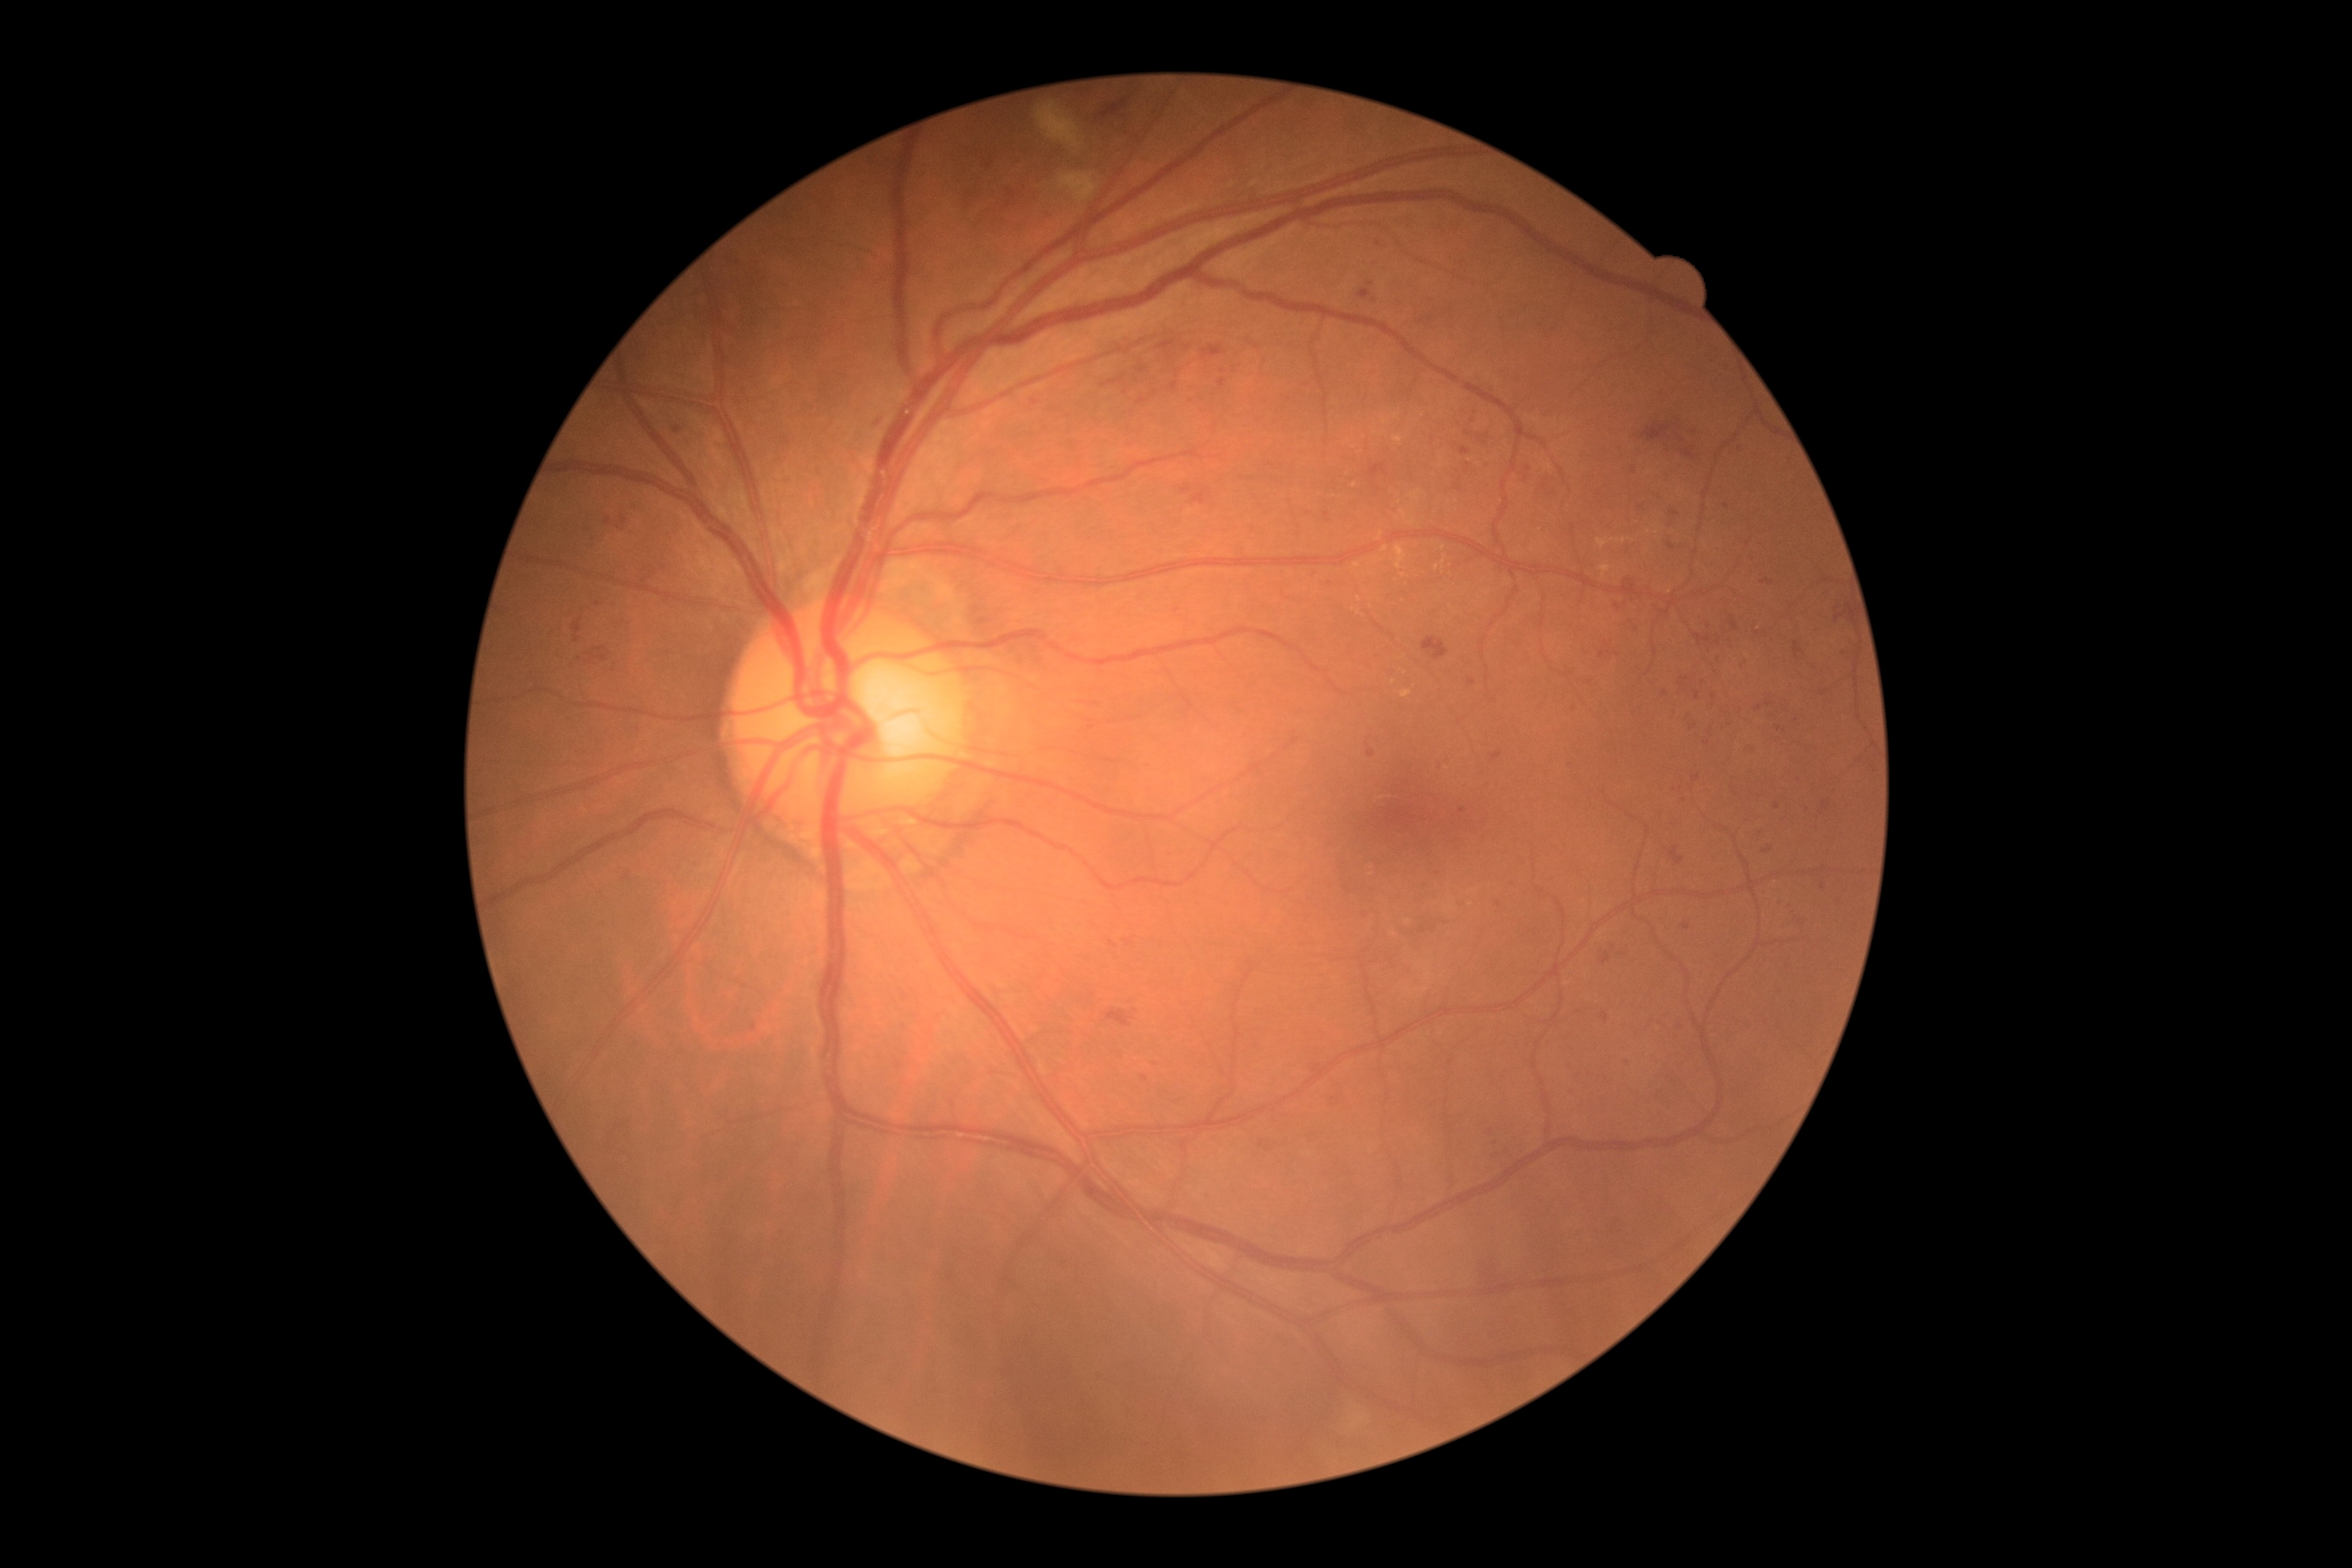
retinopathy grade@moderate NPDR (2).